2352 by 1568 pixels
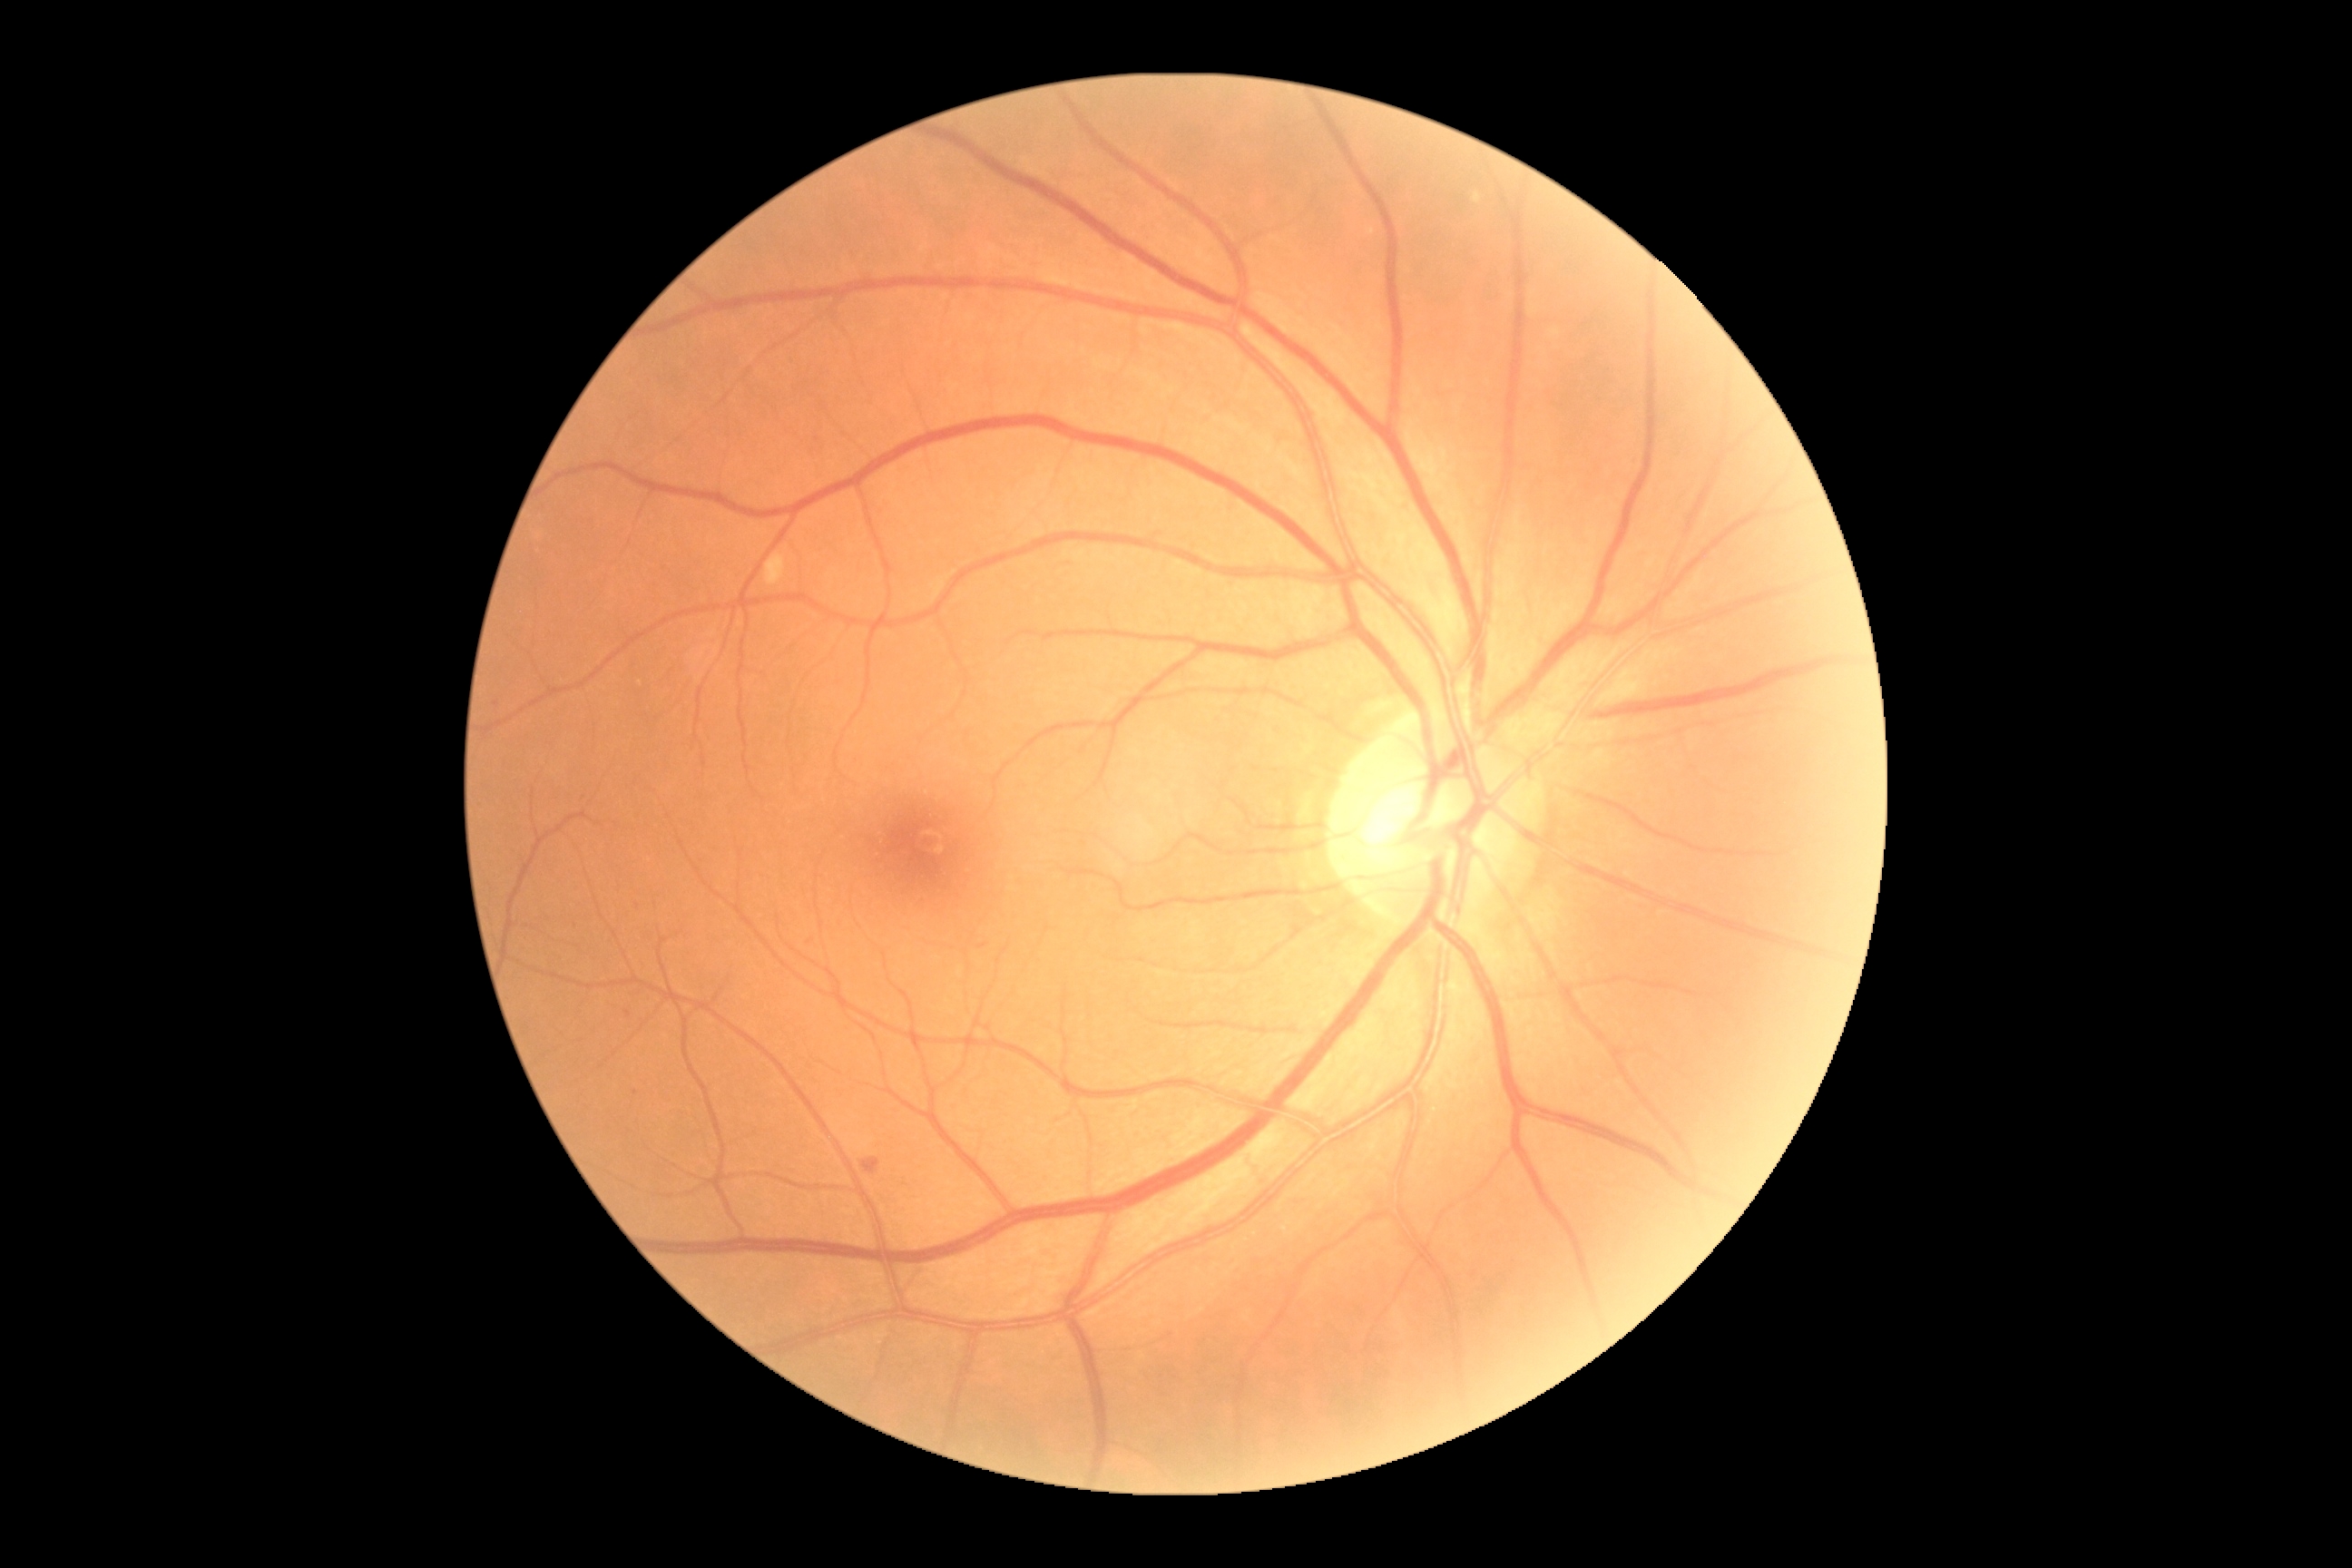

{"dr_grade": "grade 2 — more than just microaneurysms but less than severe NPDR"}